Centered on the macula.
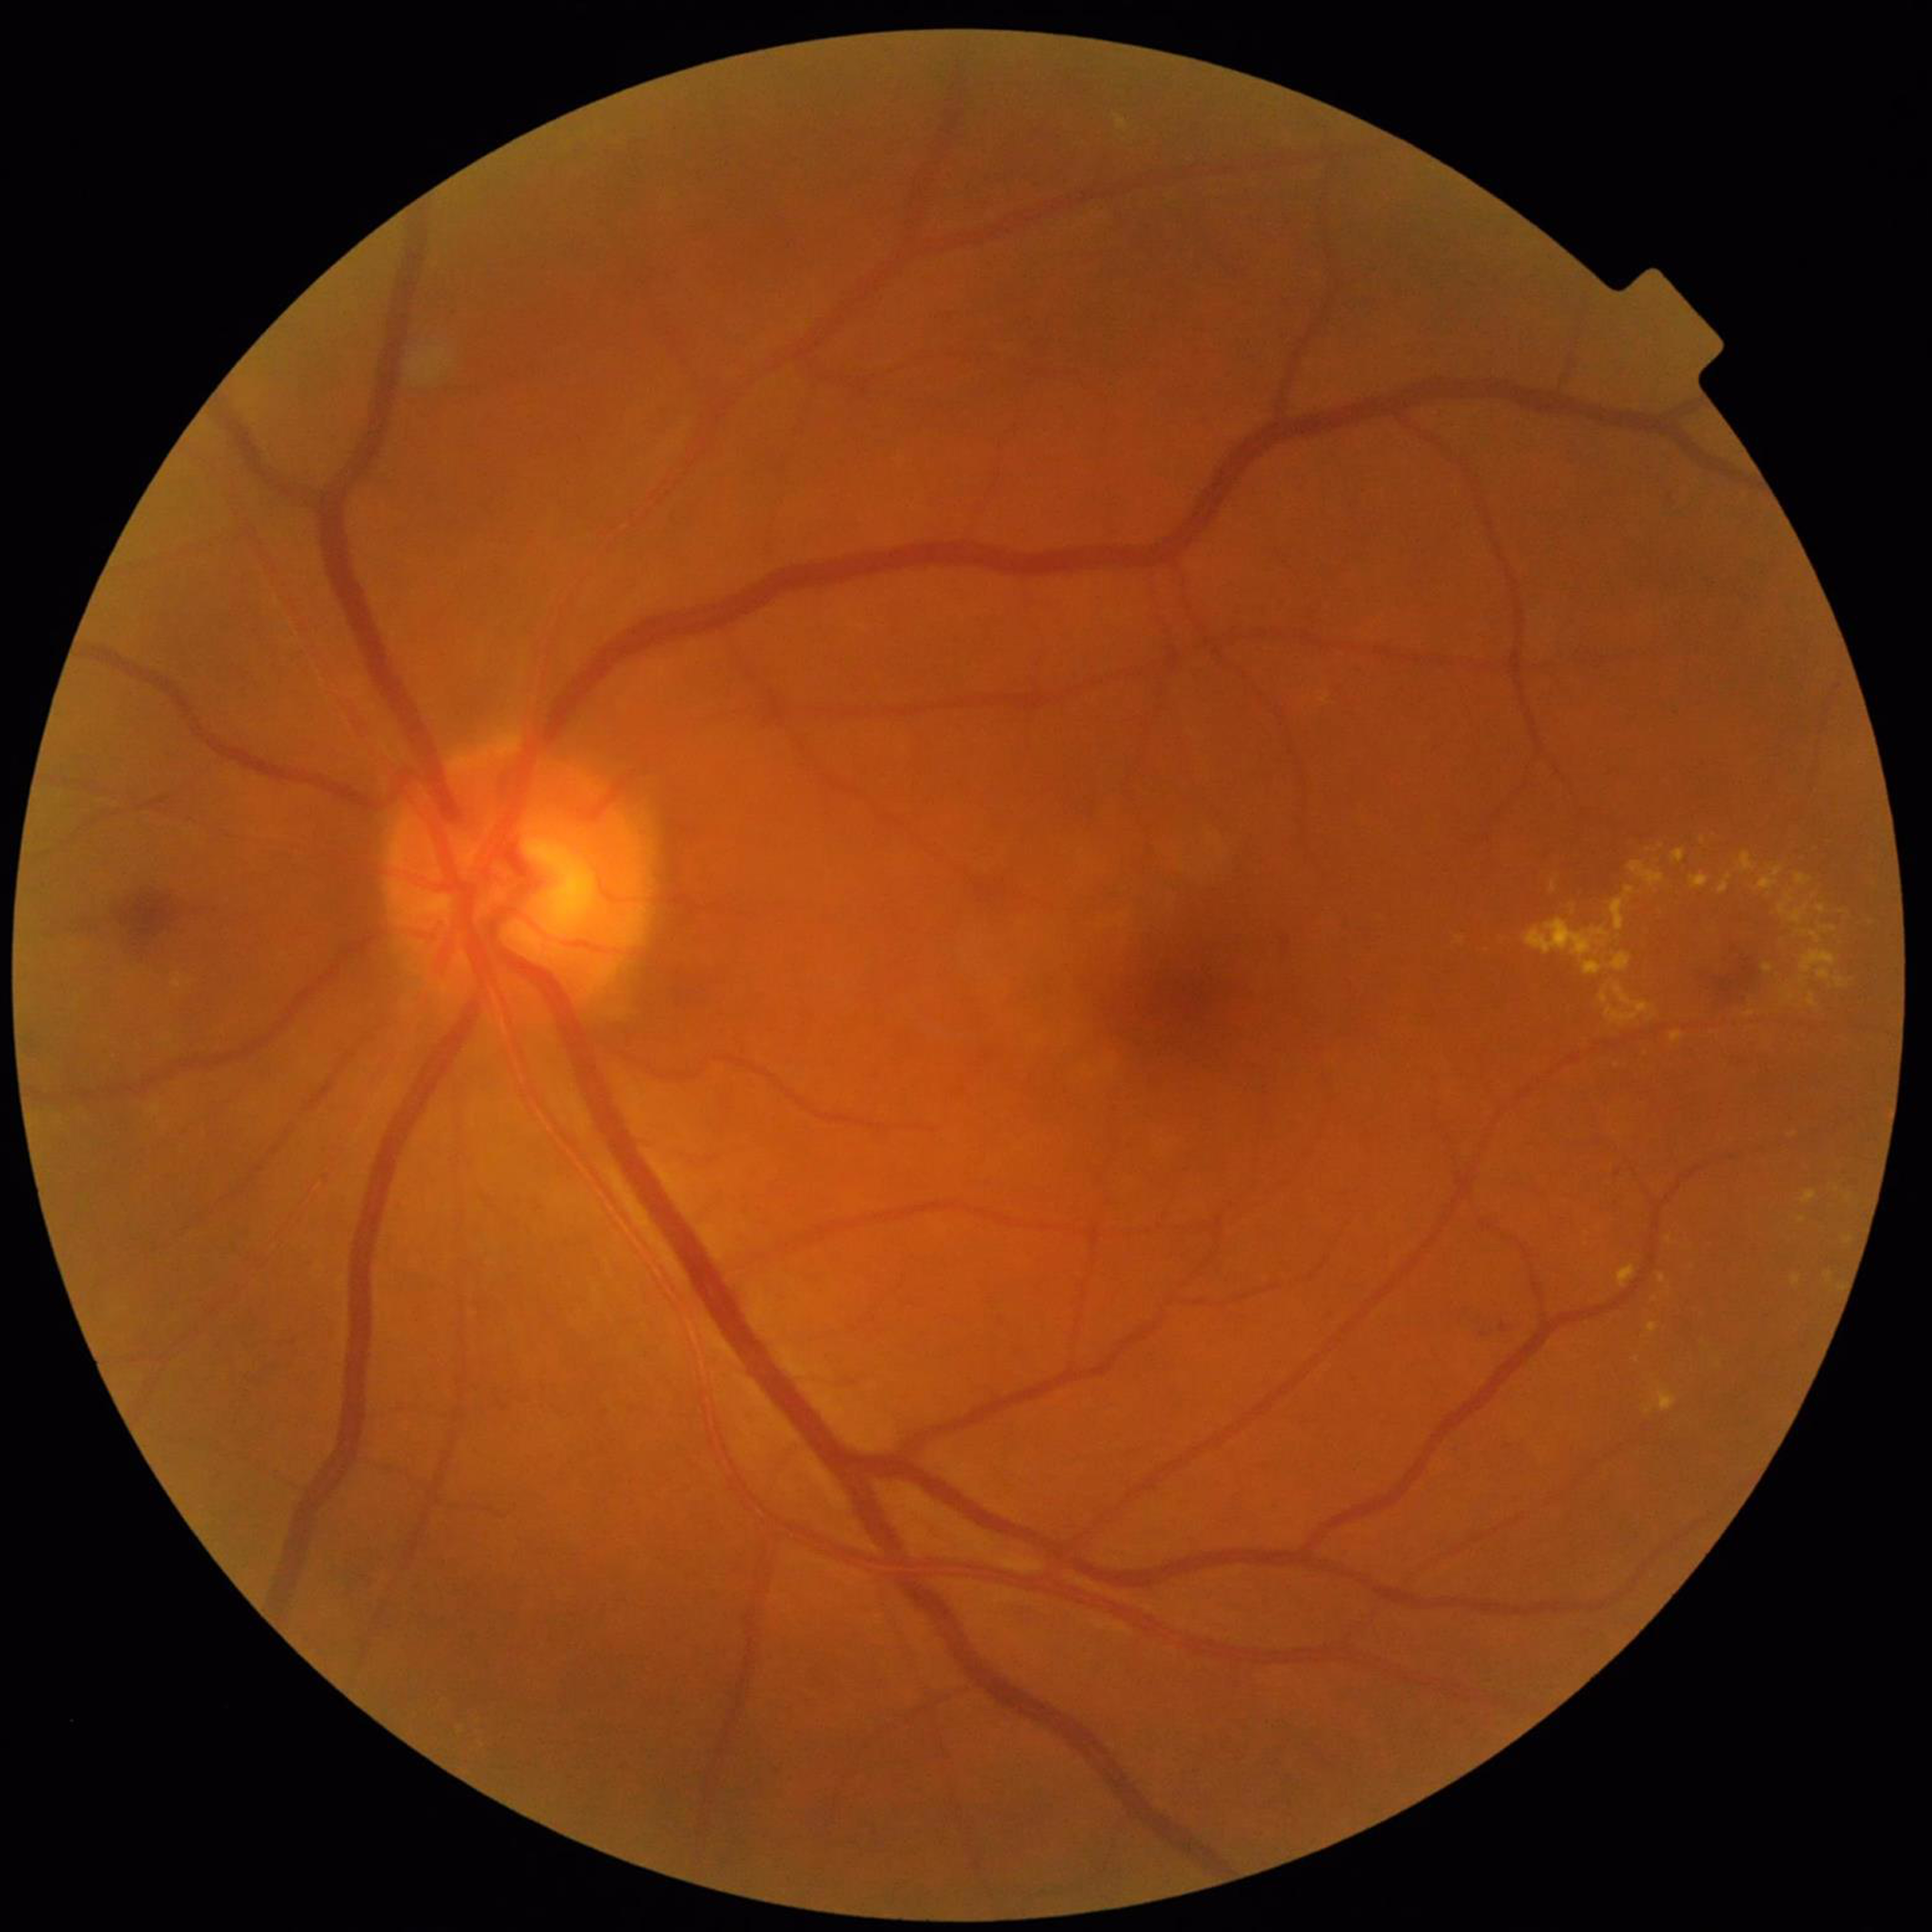

Disease class = DR